Color fundus image; 50° field of view; posterior pole field covering the optic disc and macula.
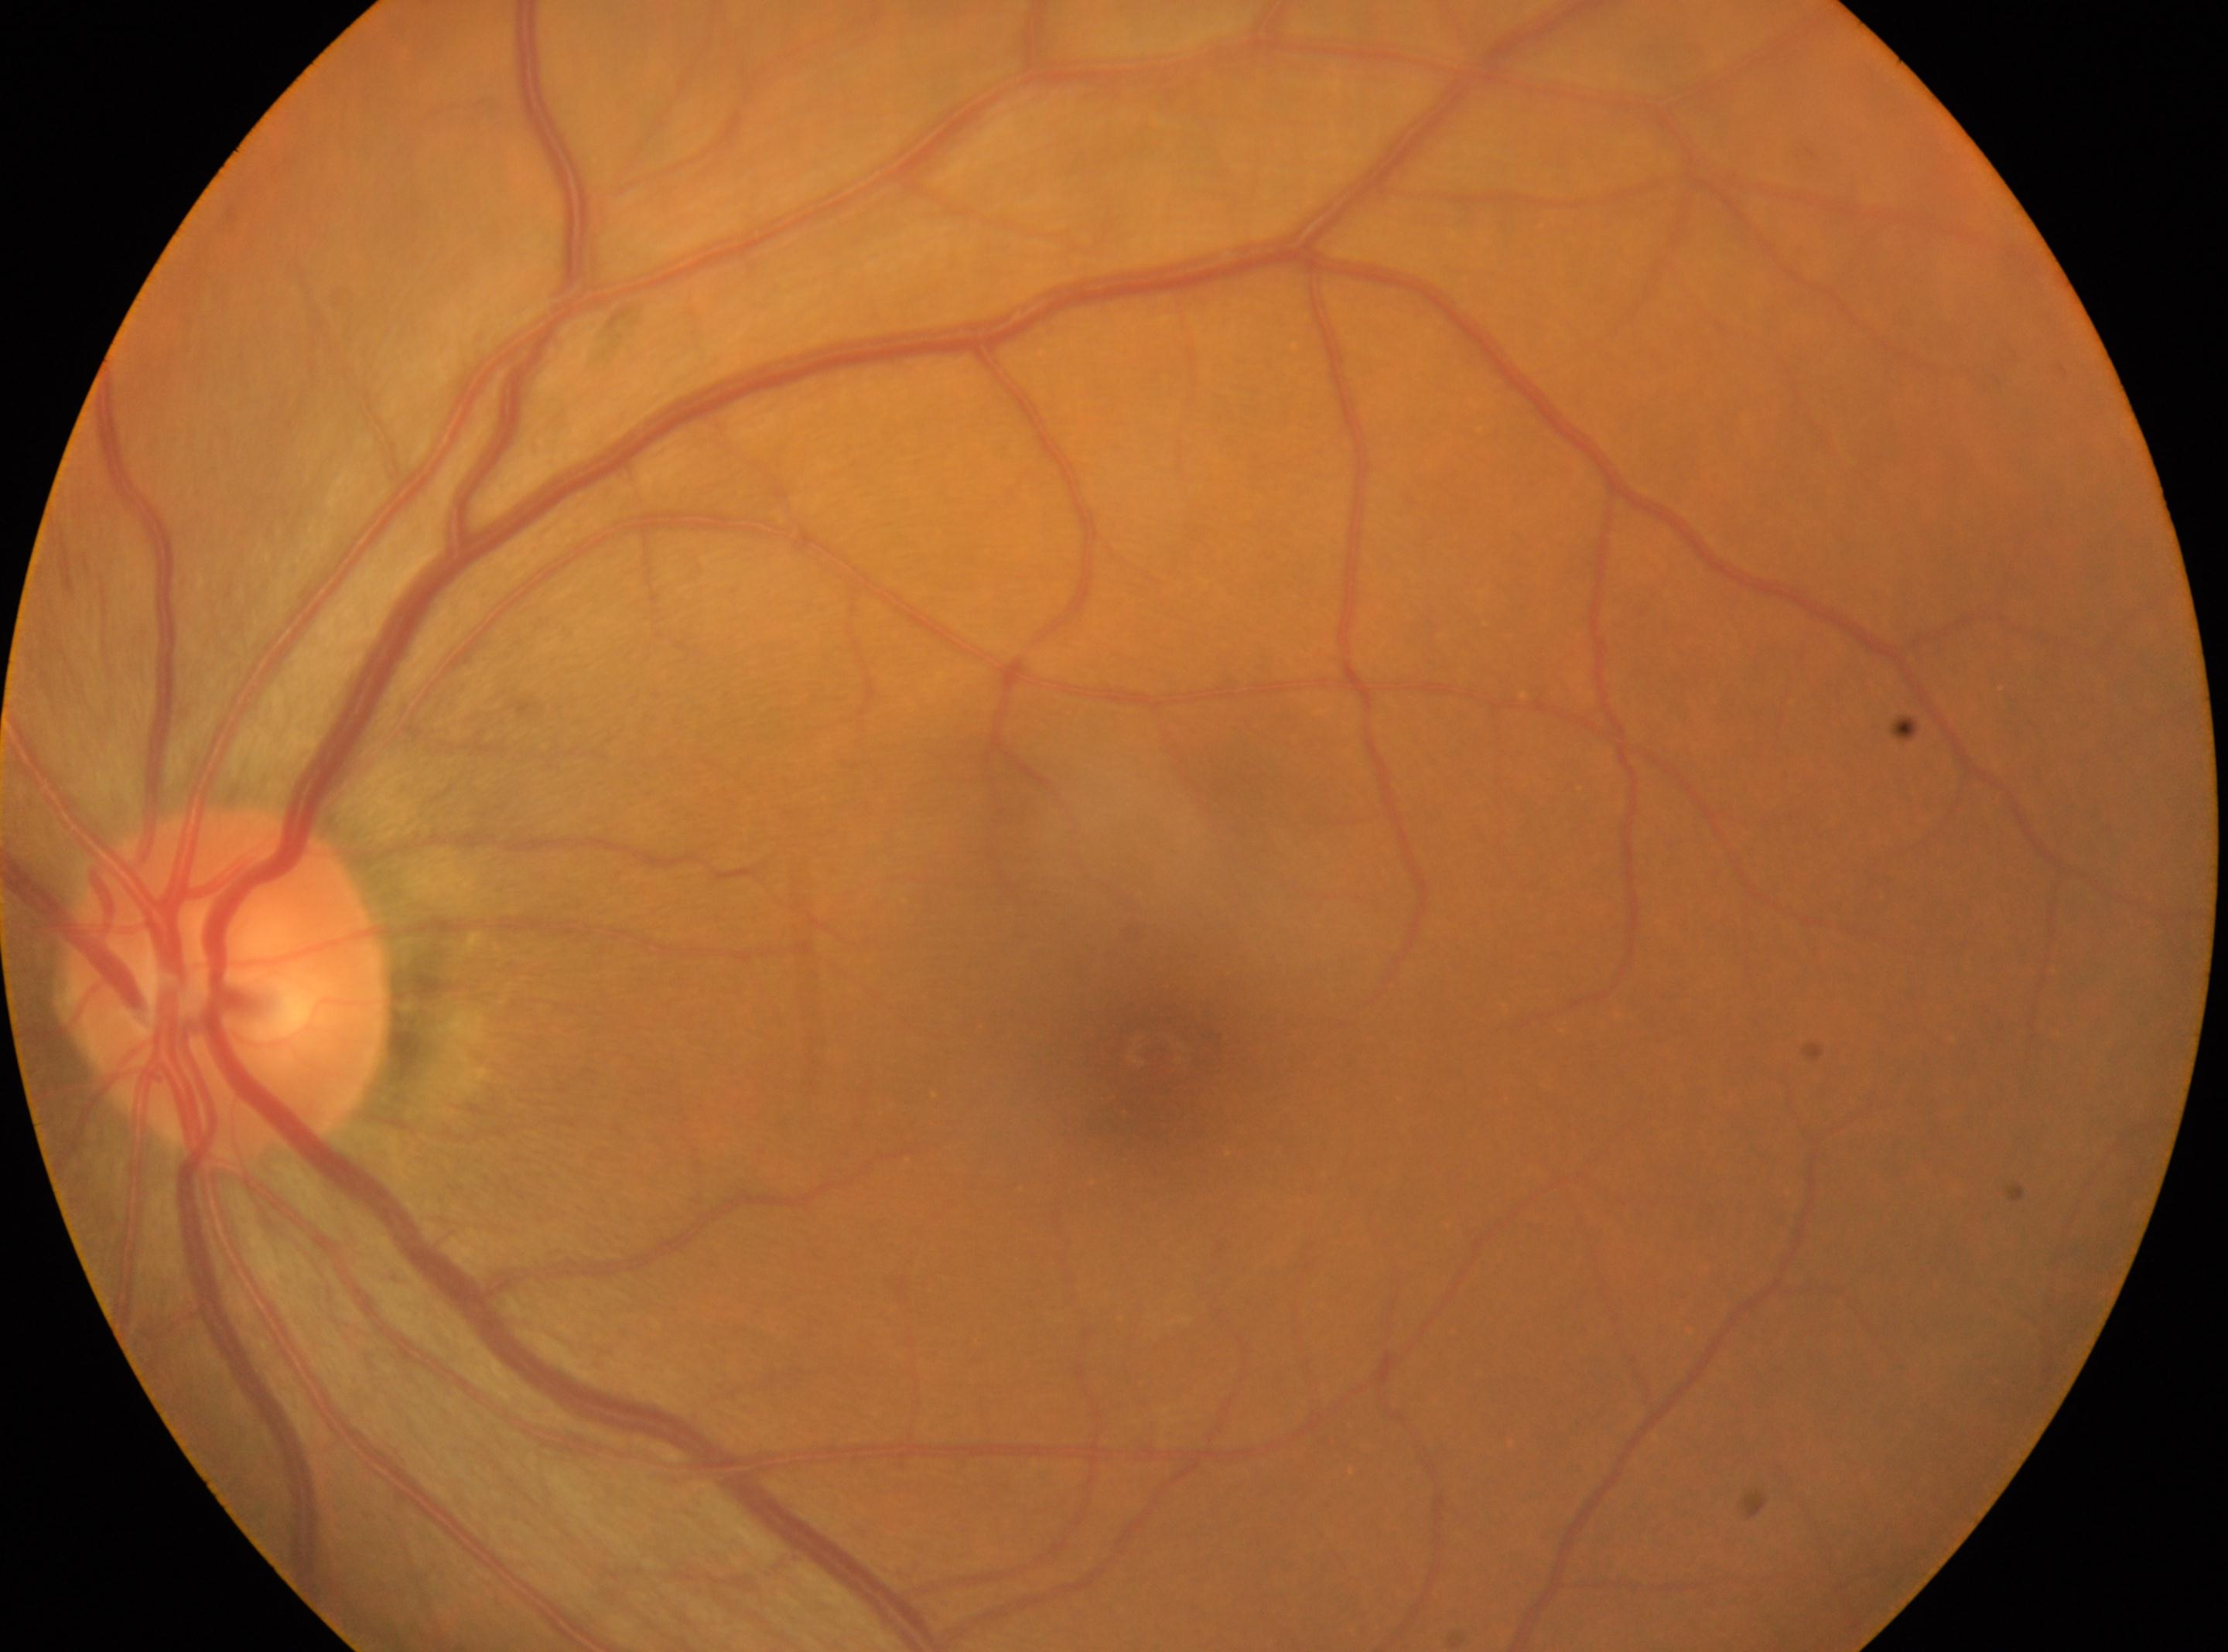

disc center = (226,987), laterality = left eye, DR = 0/4, fovea center = (1150,1052).